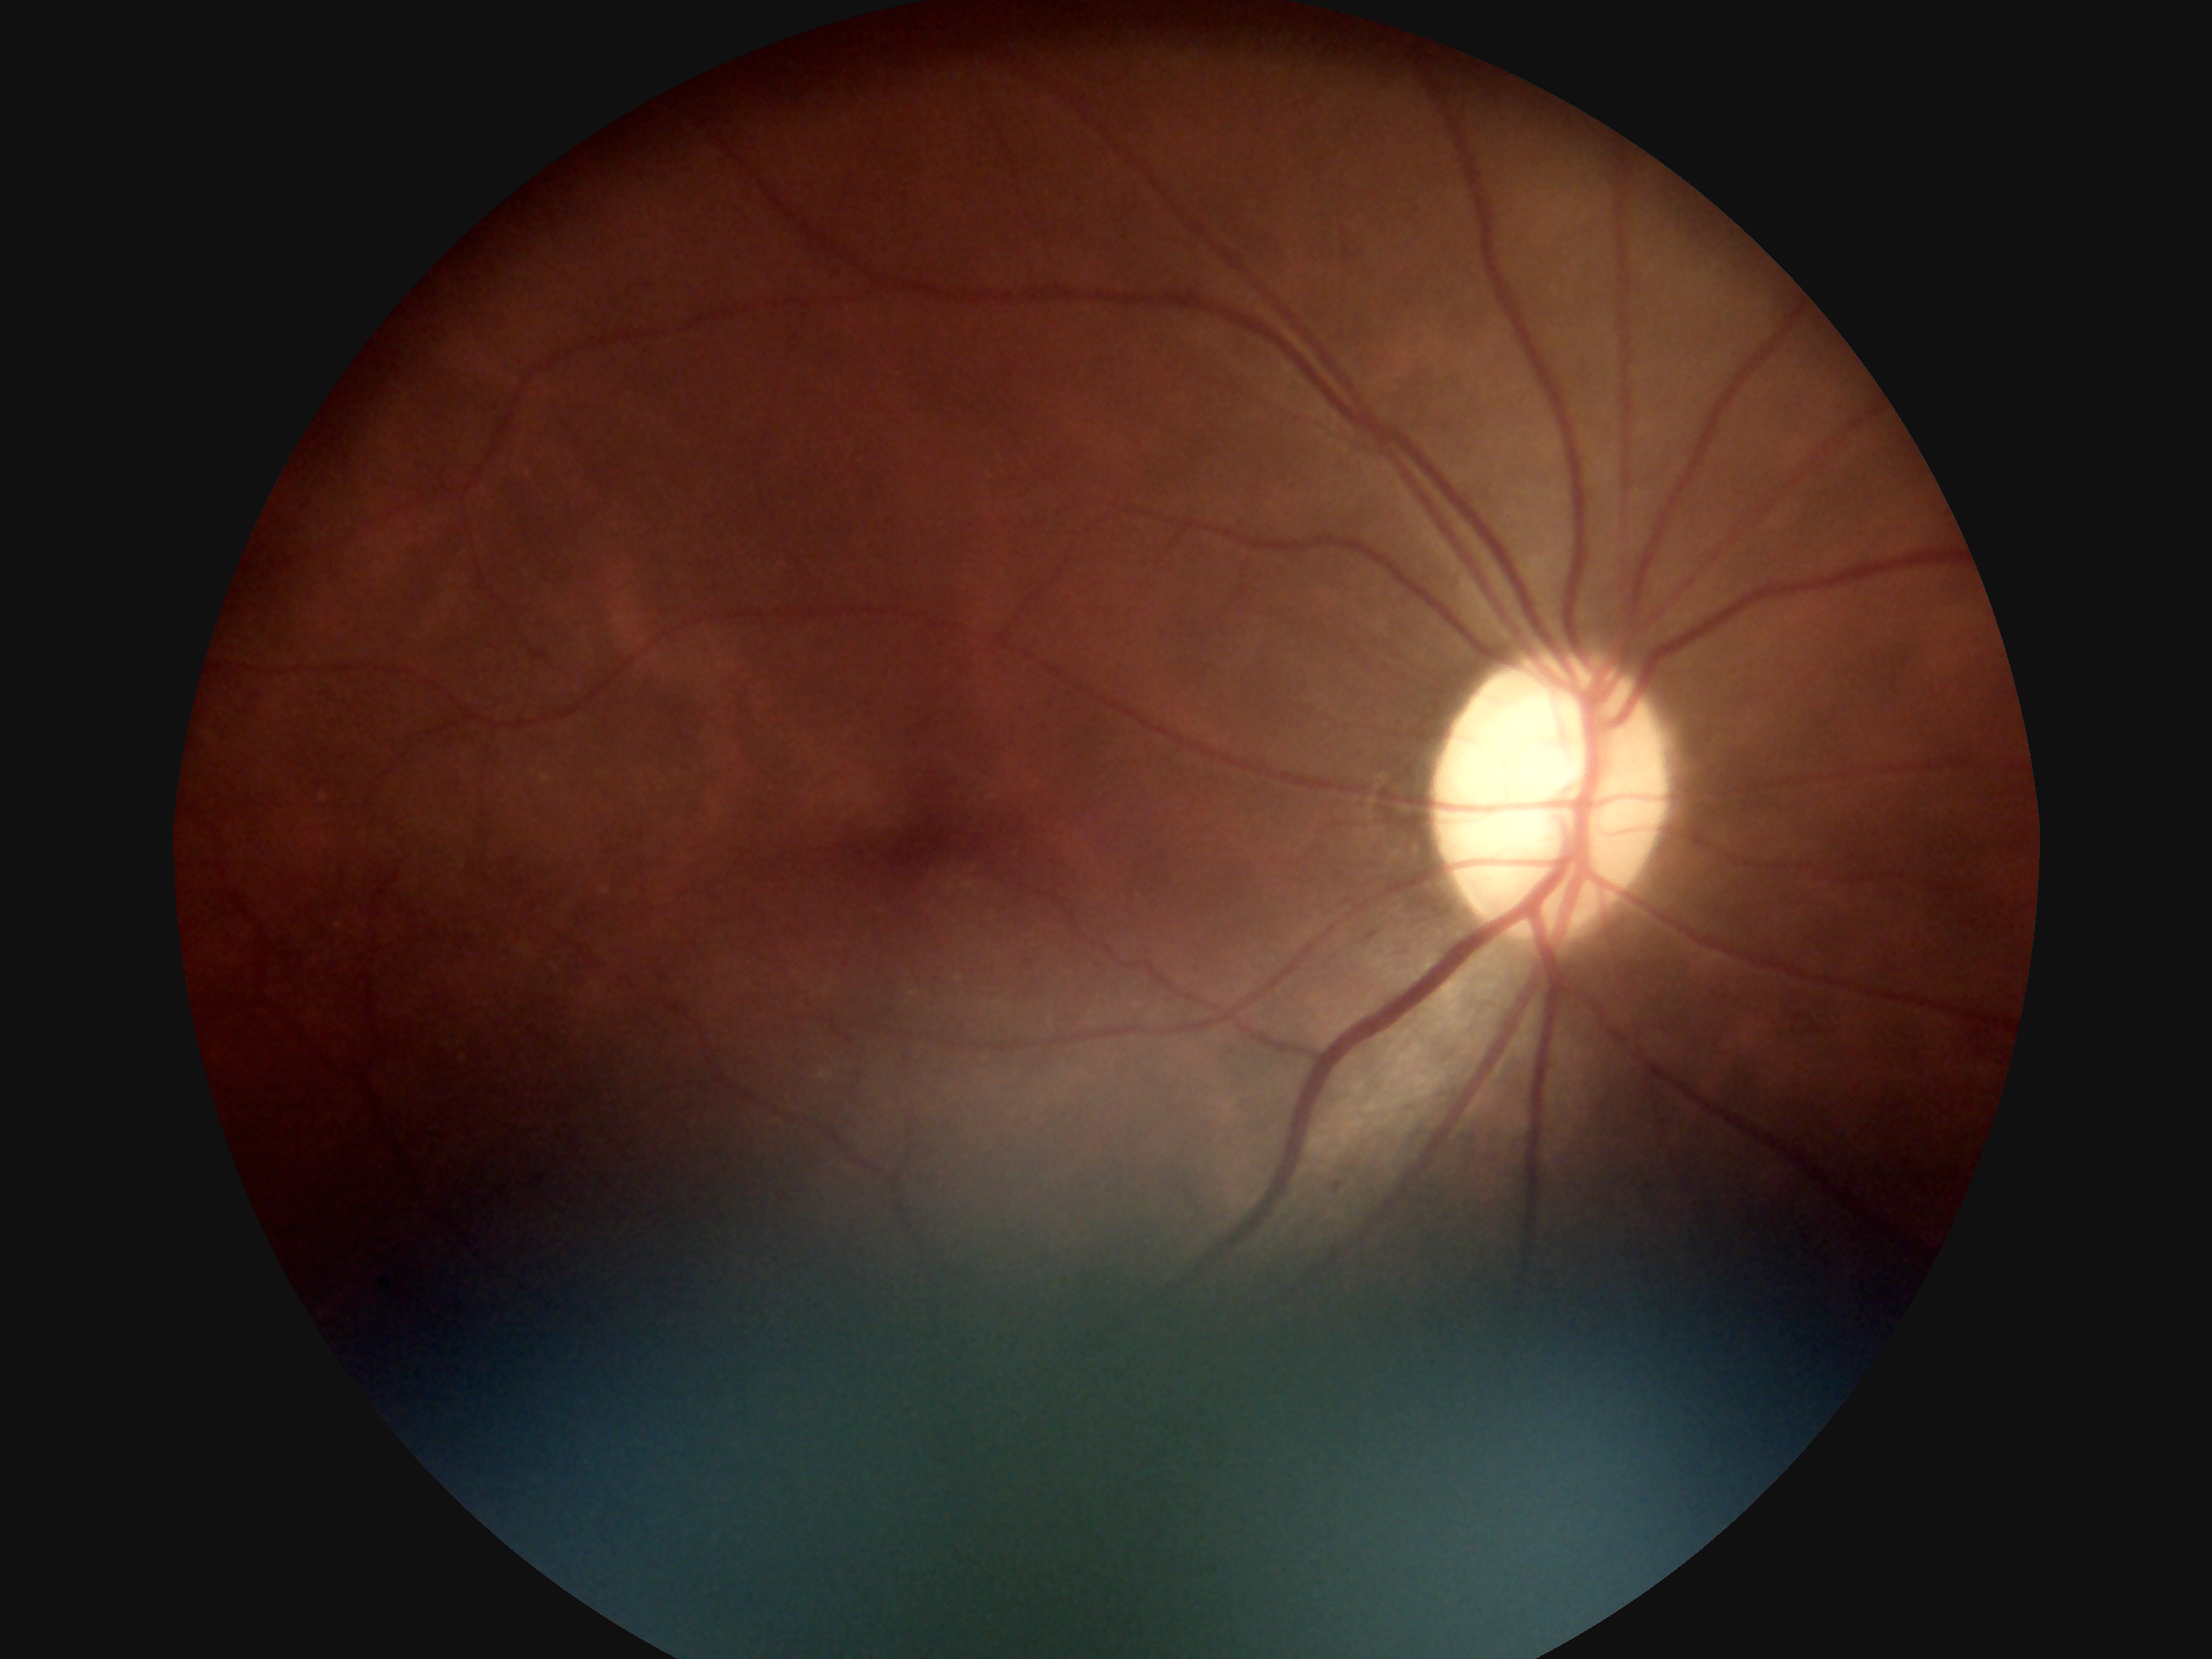
* DR severity: grade 1 (mild NPDR)
* DR class: non-proliferative diabetic retinopathy